640x480px. Wide-field fundus photograph of an infant:
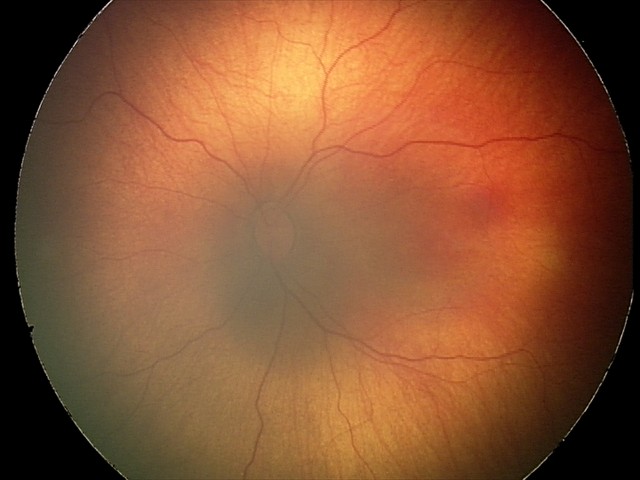 Normal screening examination.